Fundus photo.
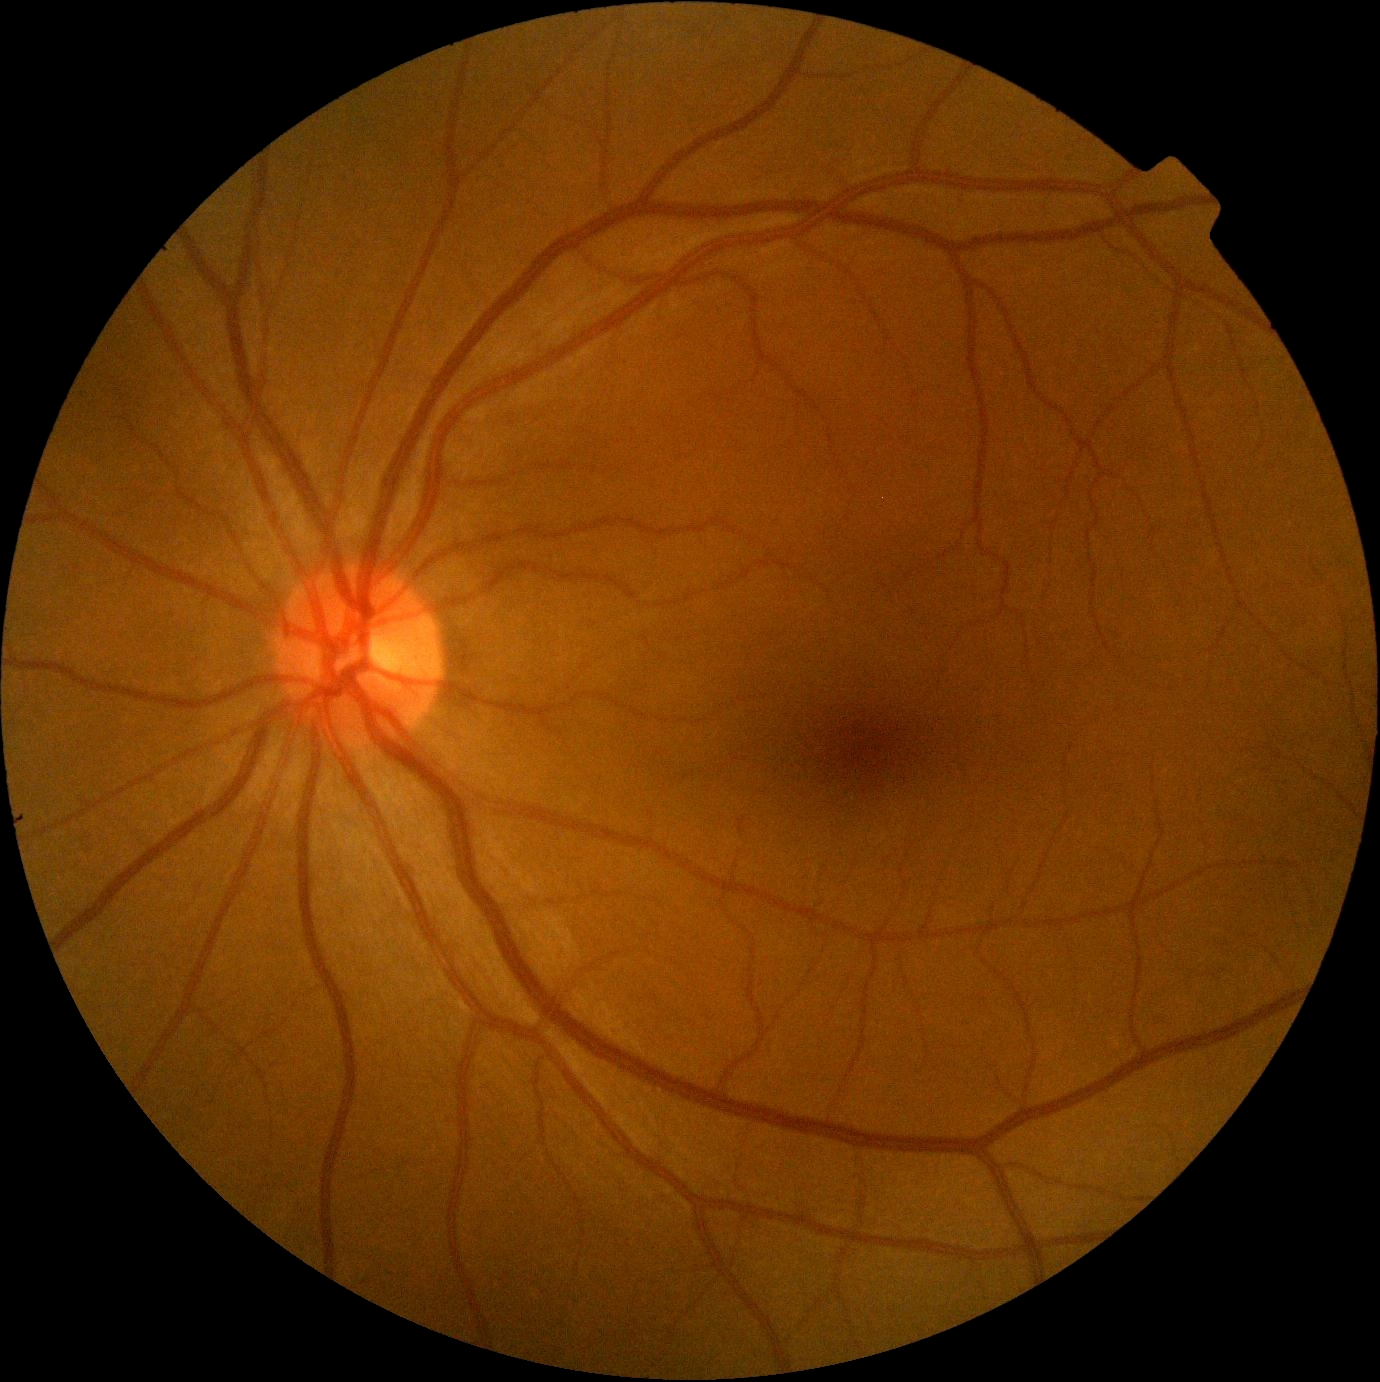 DR severity = grade 0 (no apparent retinopathy), DR impression = no DR findings.